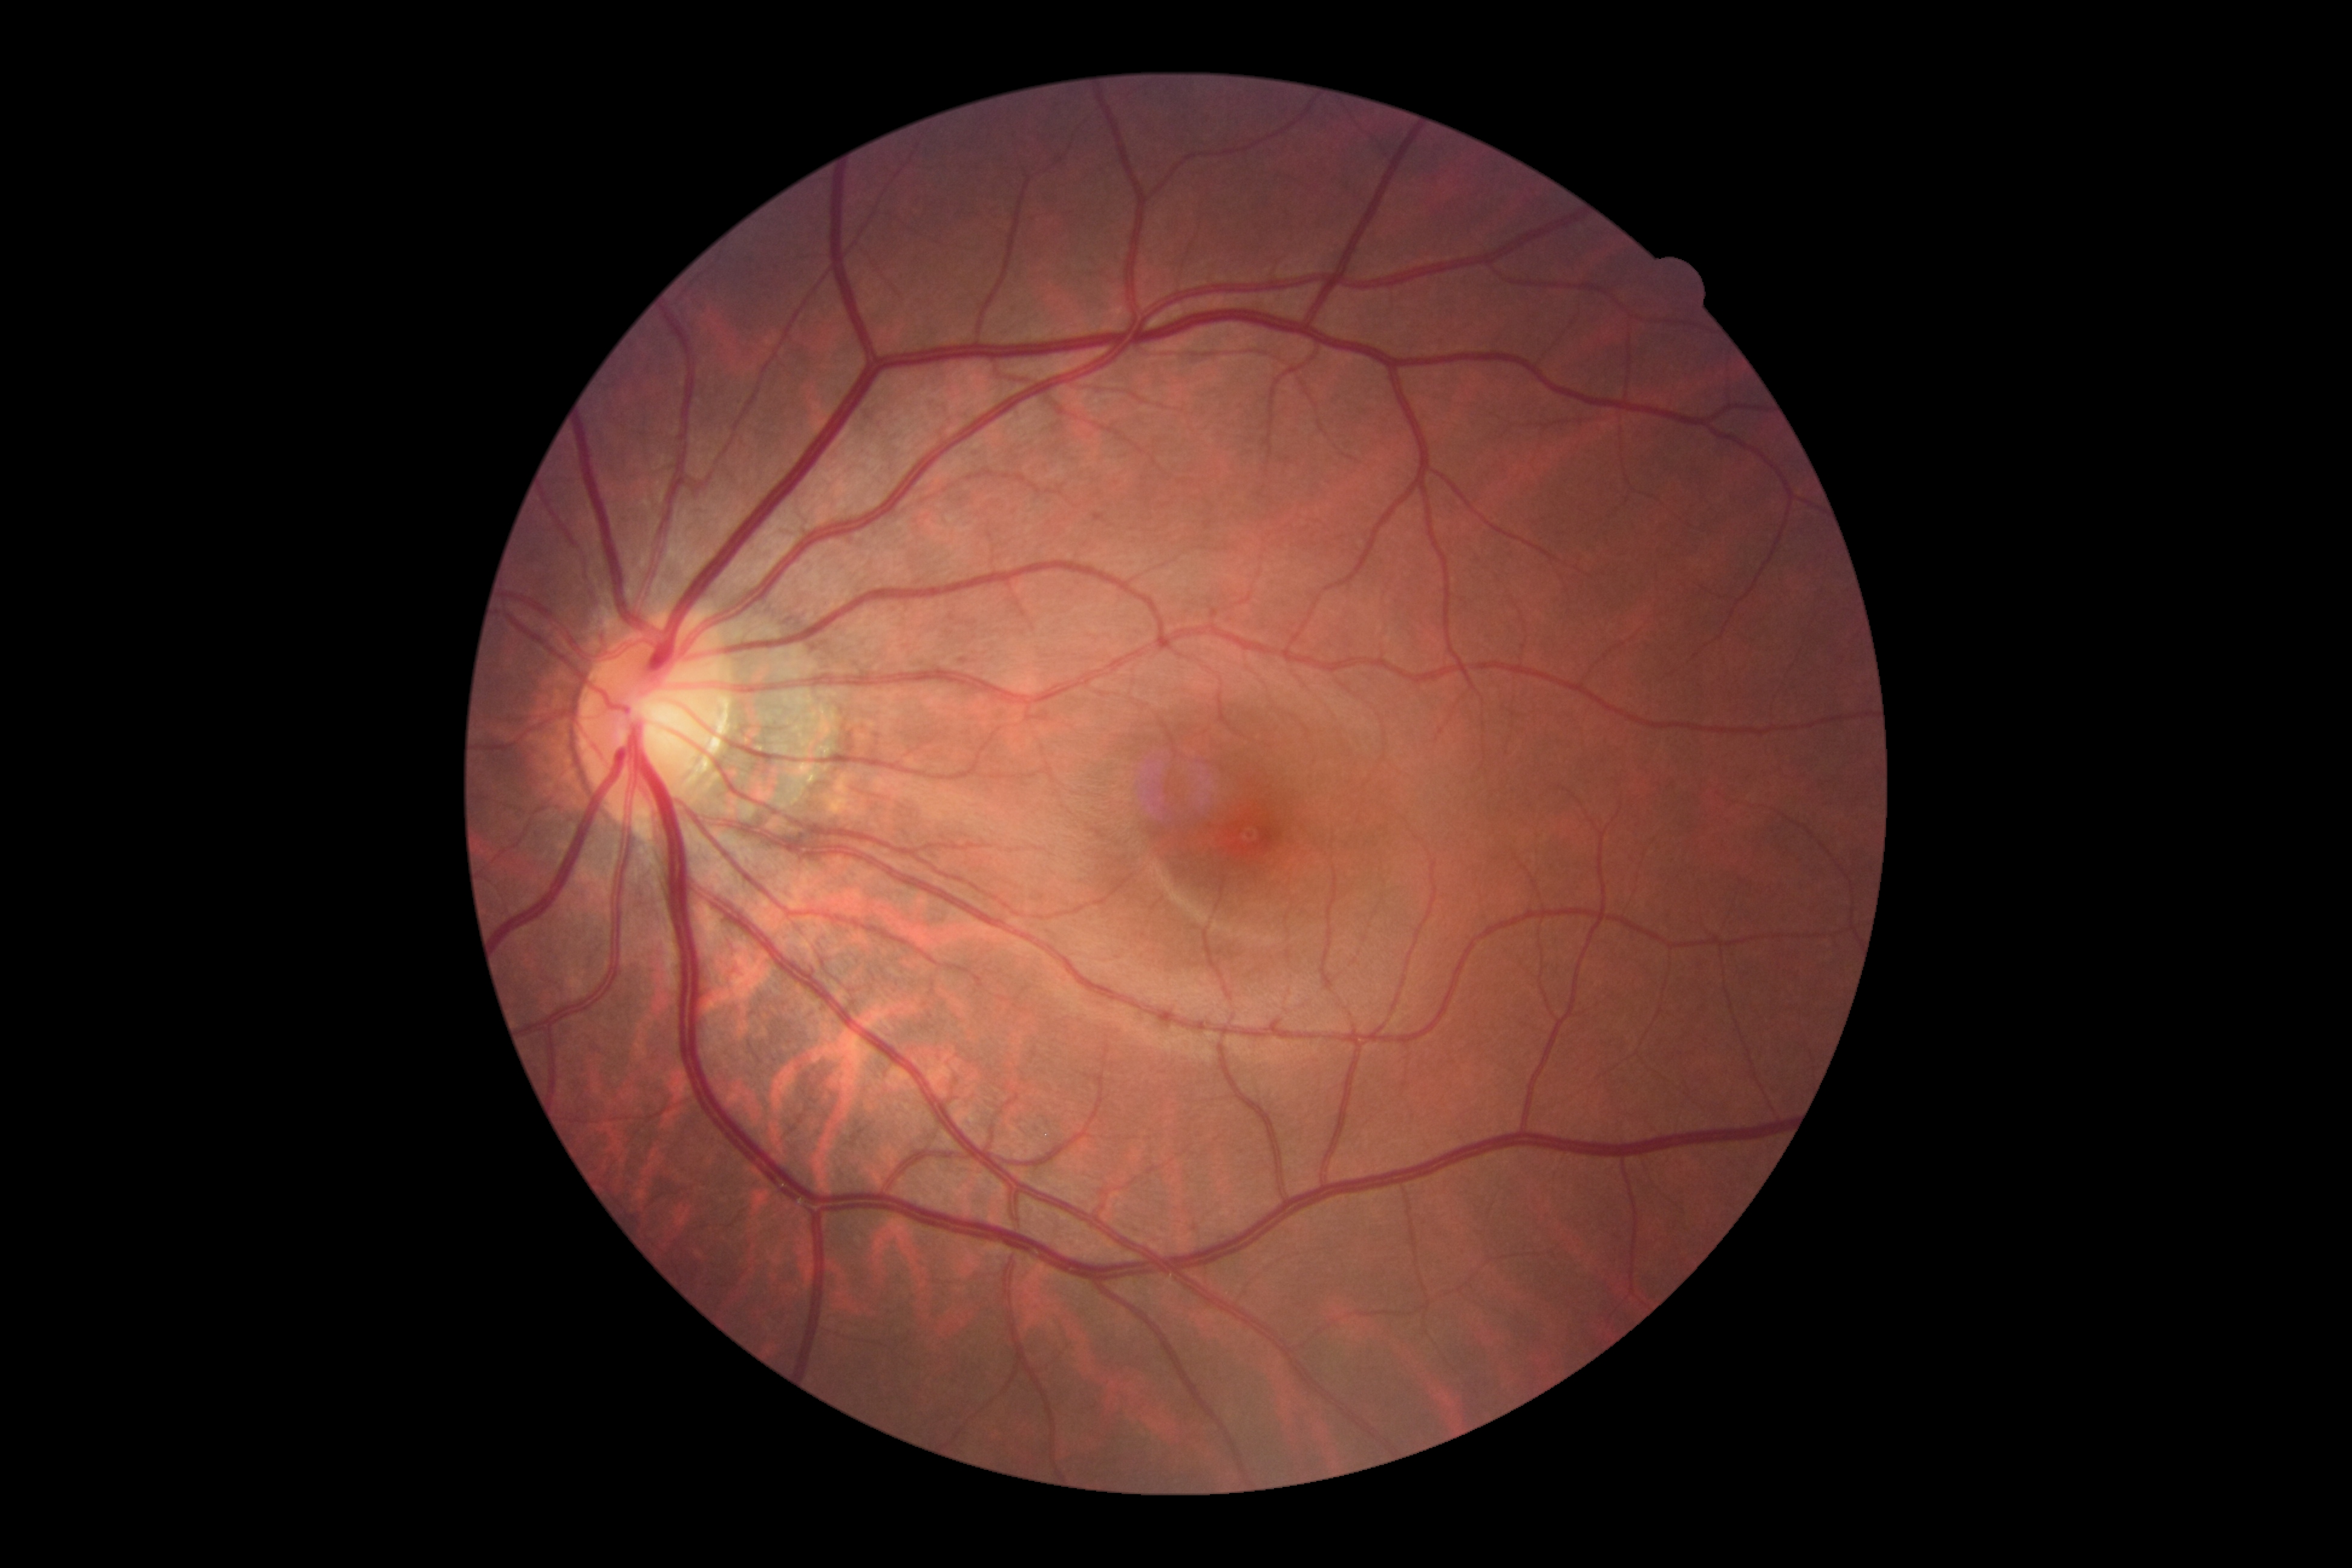

Diabetic retinopathy (DR) is 0.